45° field of view. 1470x1473. Color fundus image:
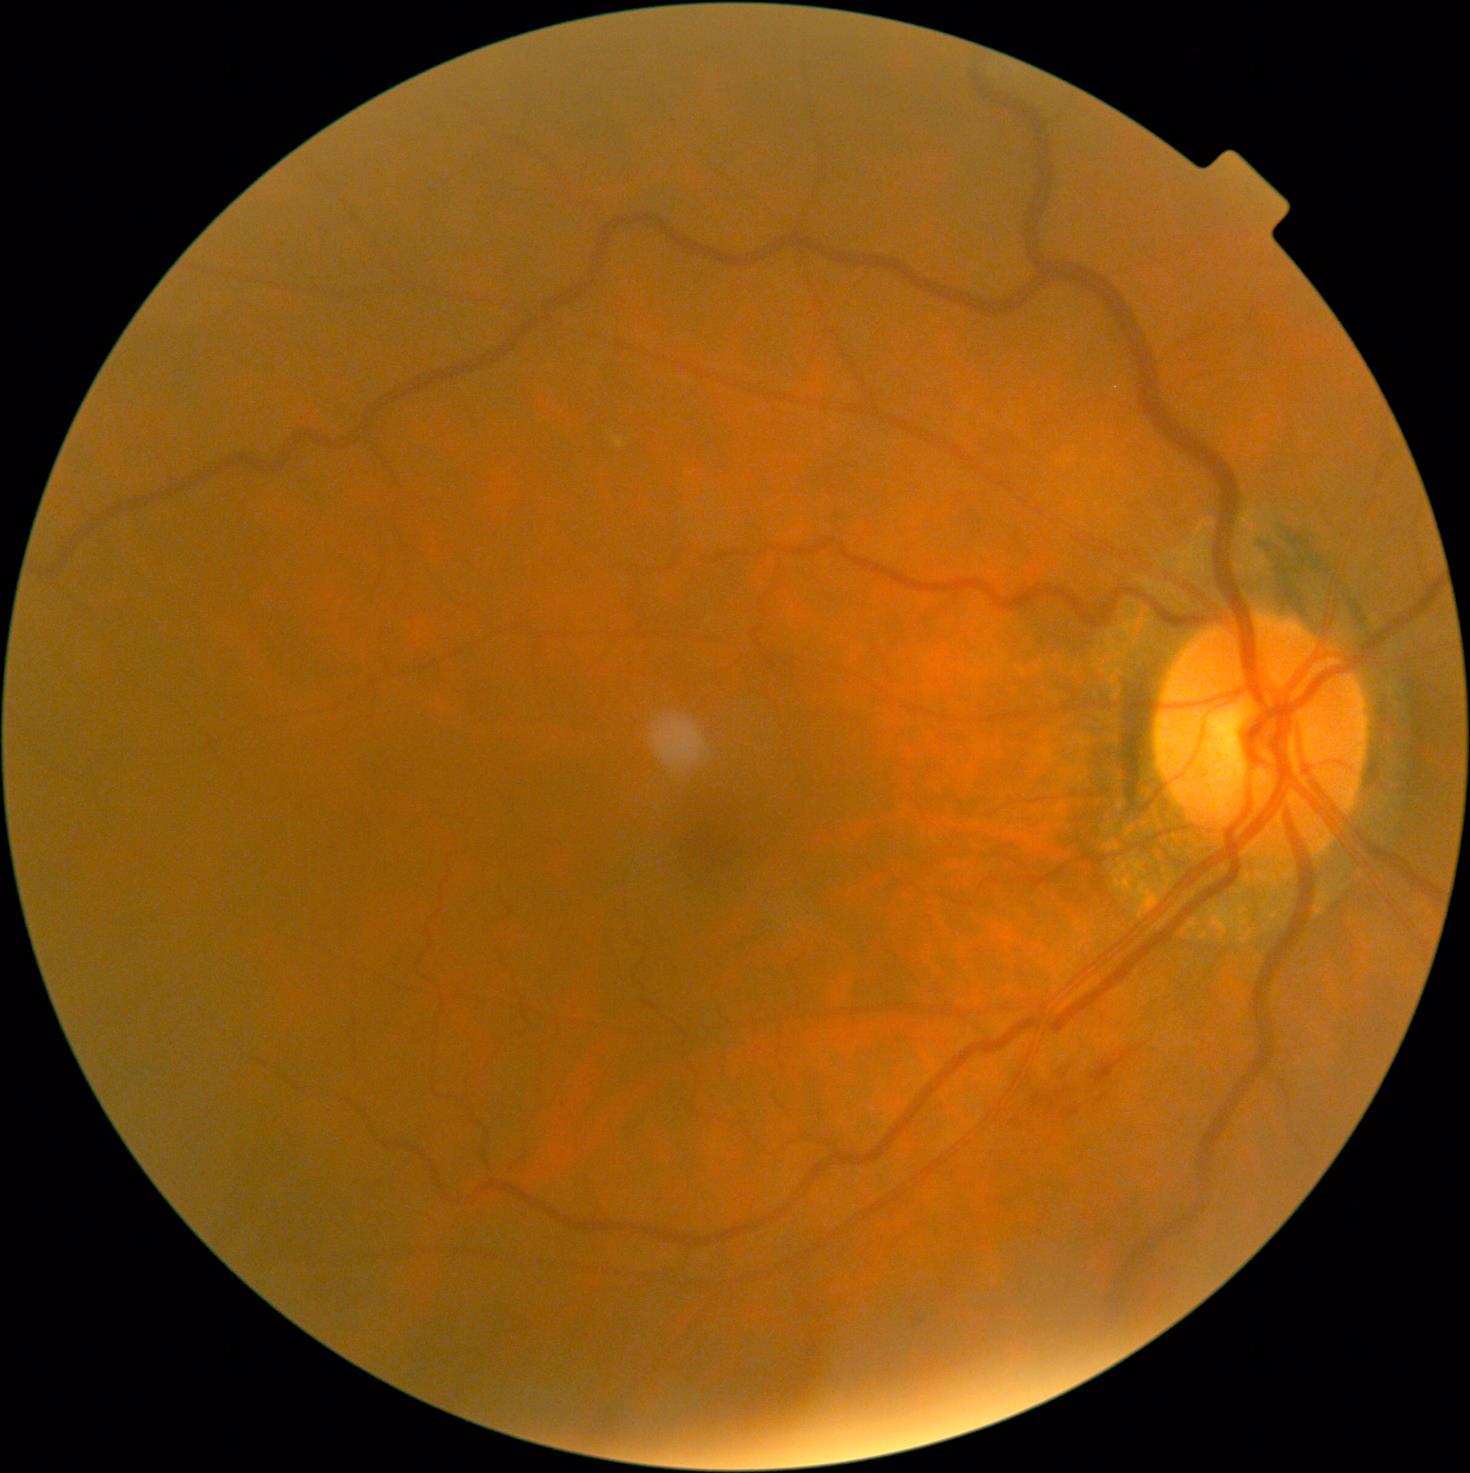
Diabetic retinopathy grade is 2 (moderate NPDR).